Pediatric wide-field fundus photograph · Phoenix ICON, 100° FOV · 1240 x 1240 pixels:
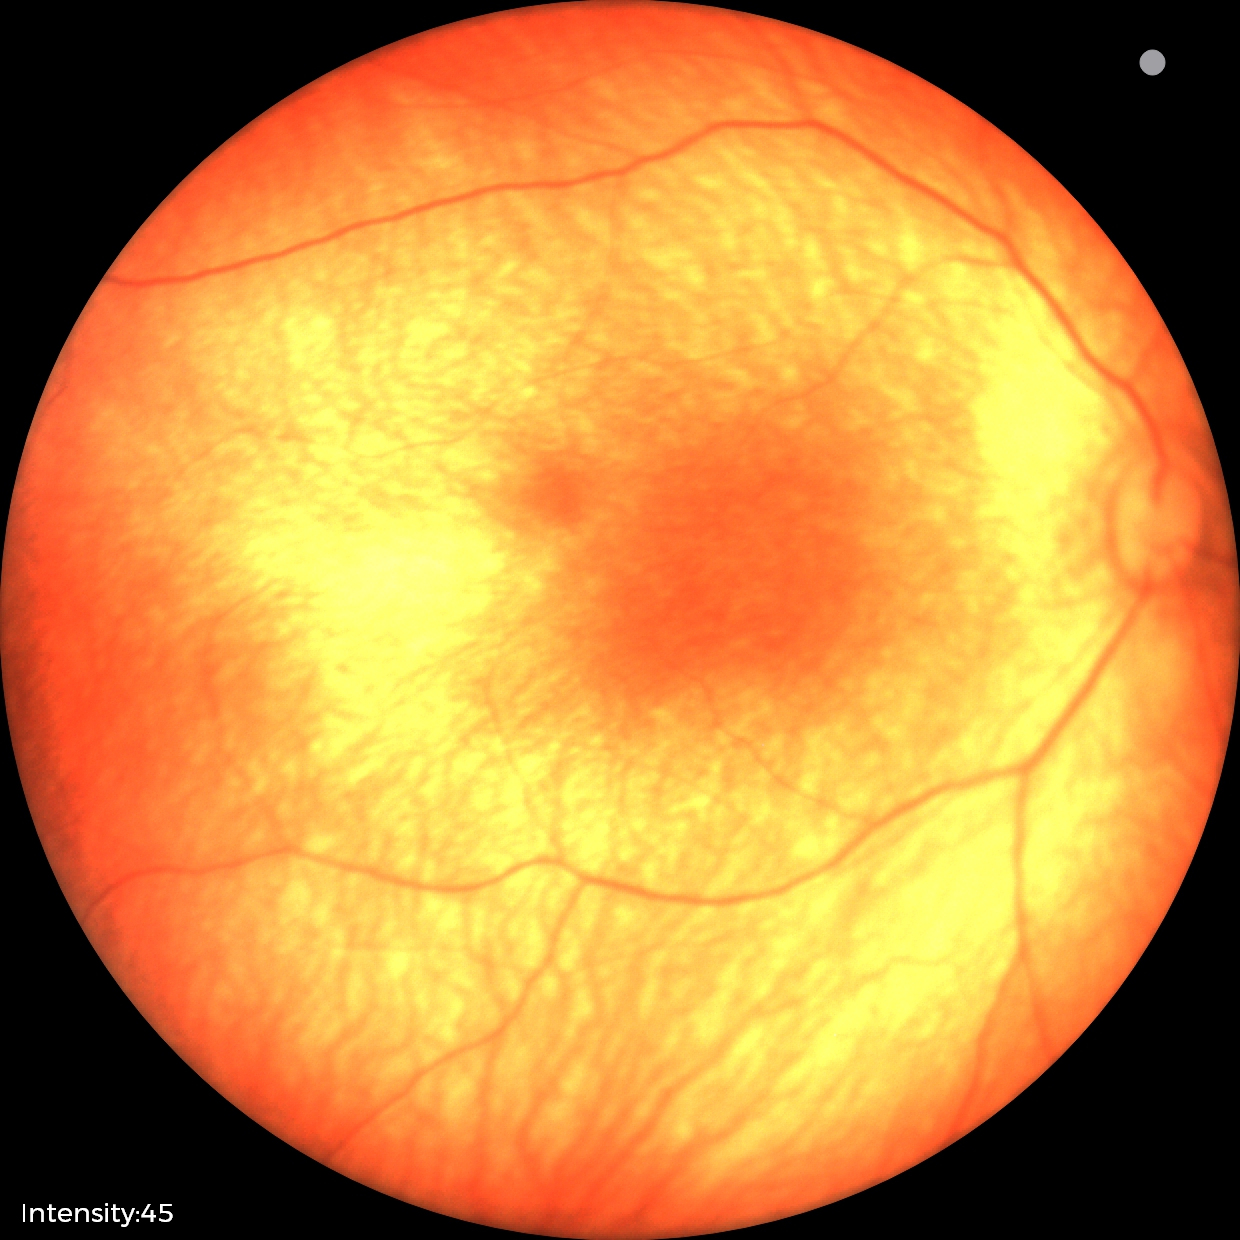
Normal screening examination.